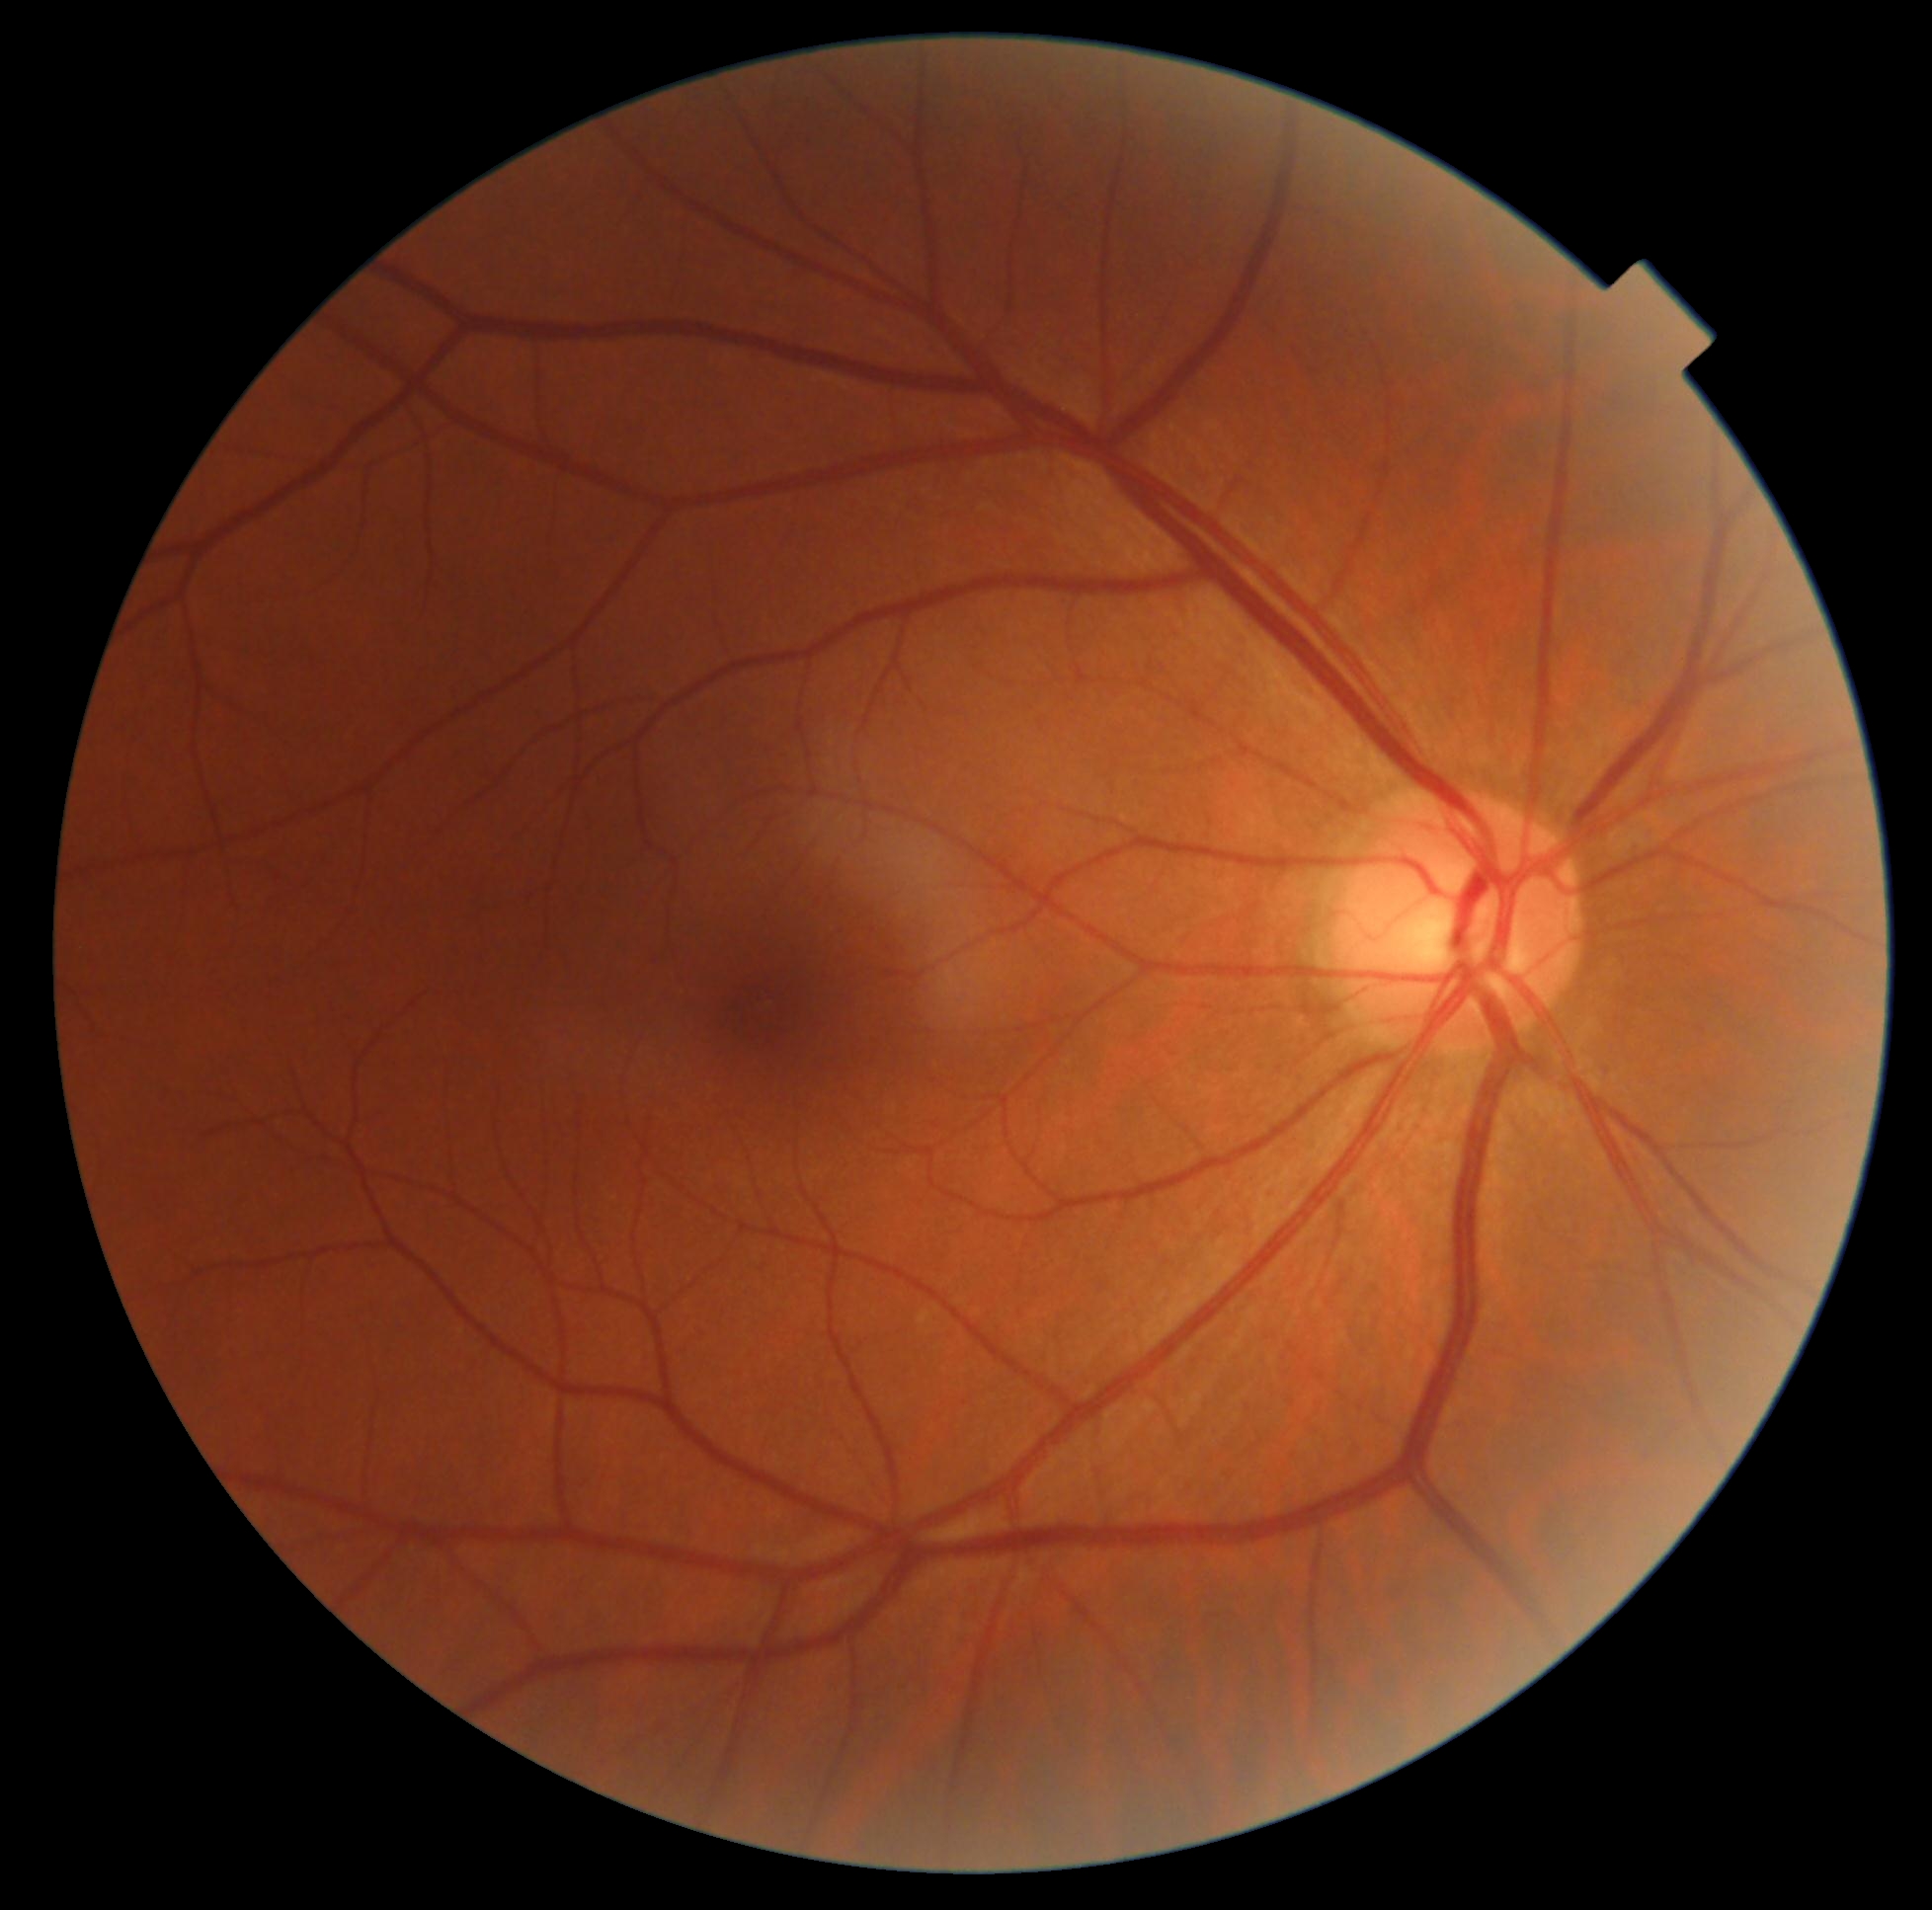
diabetic retinopathy (DR) = grade 0 (no apparent retinopathy).